Acquired with a NIDEK AFC-230. Modified Davis classification.
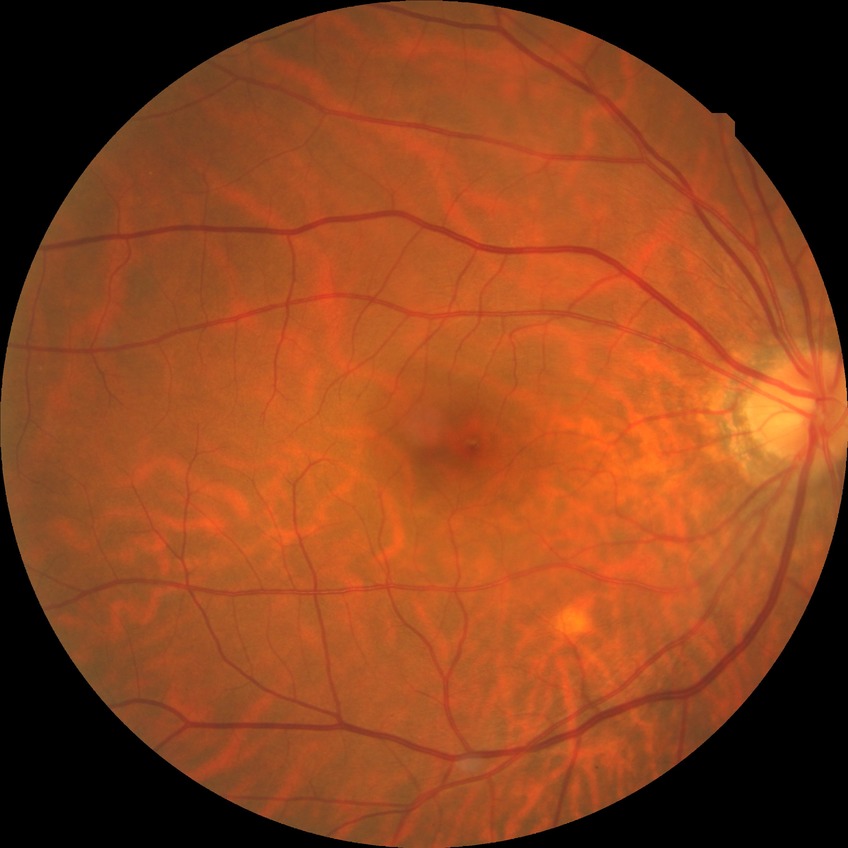 Diabetic retinopathy stage: no diabetic retinopathy.